45-degree field of view, fundus photo, 2048 by 1536 pixels:
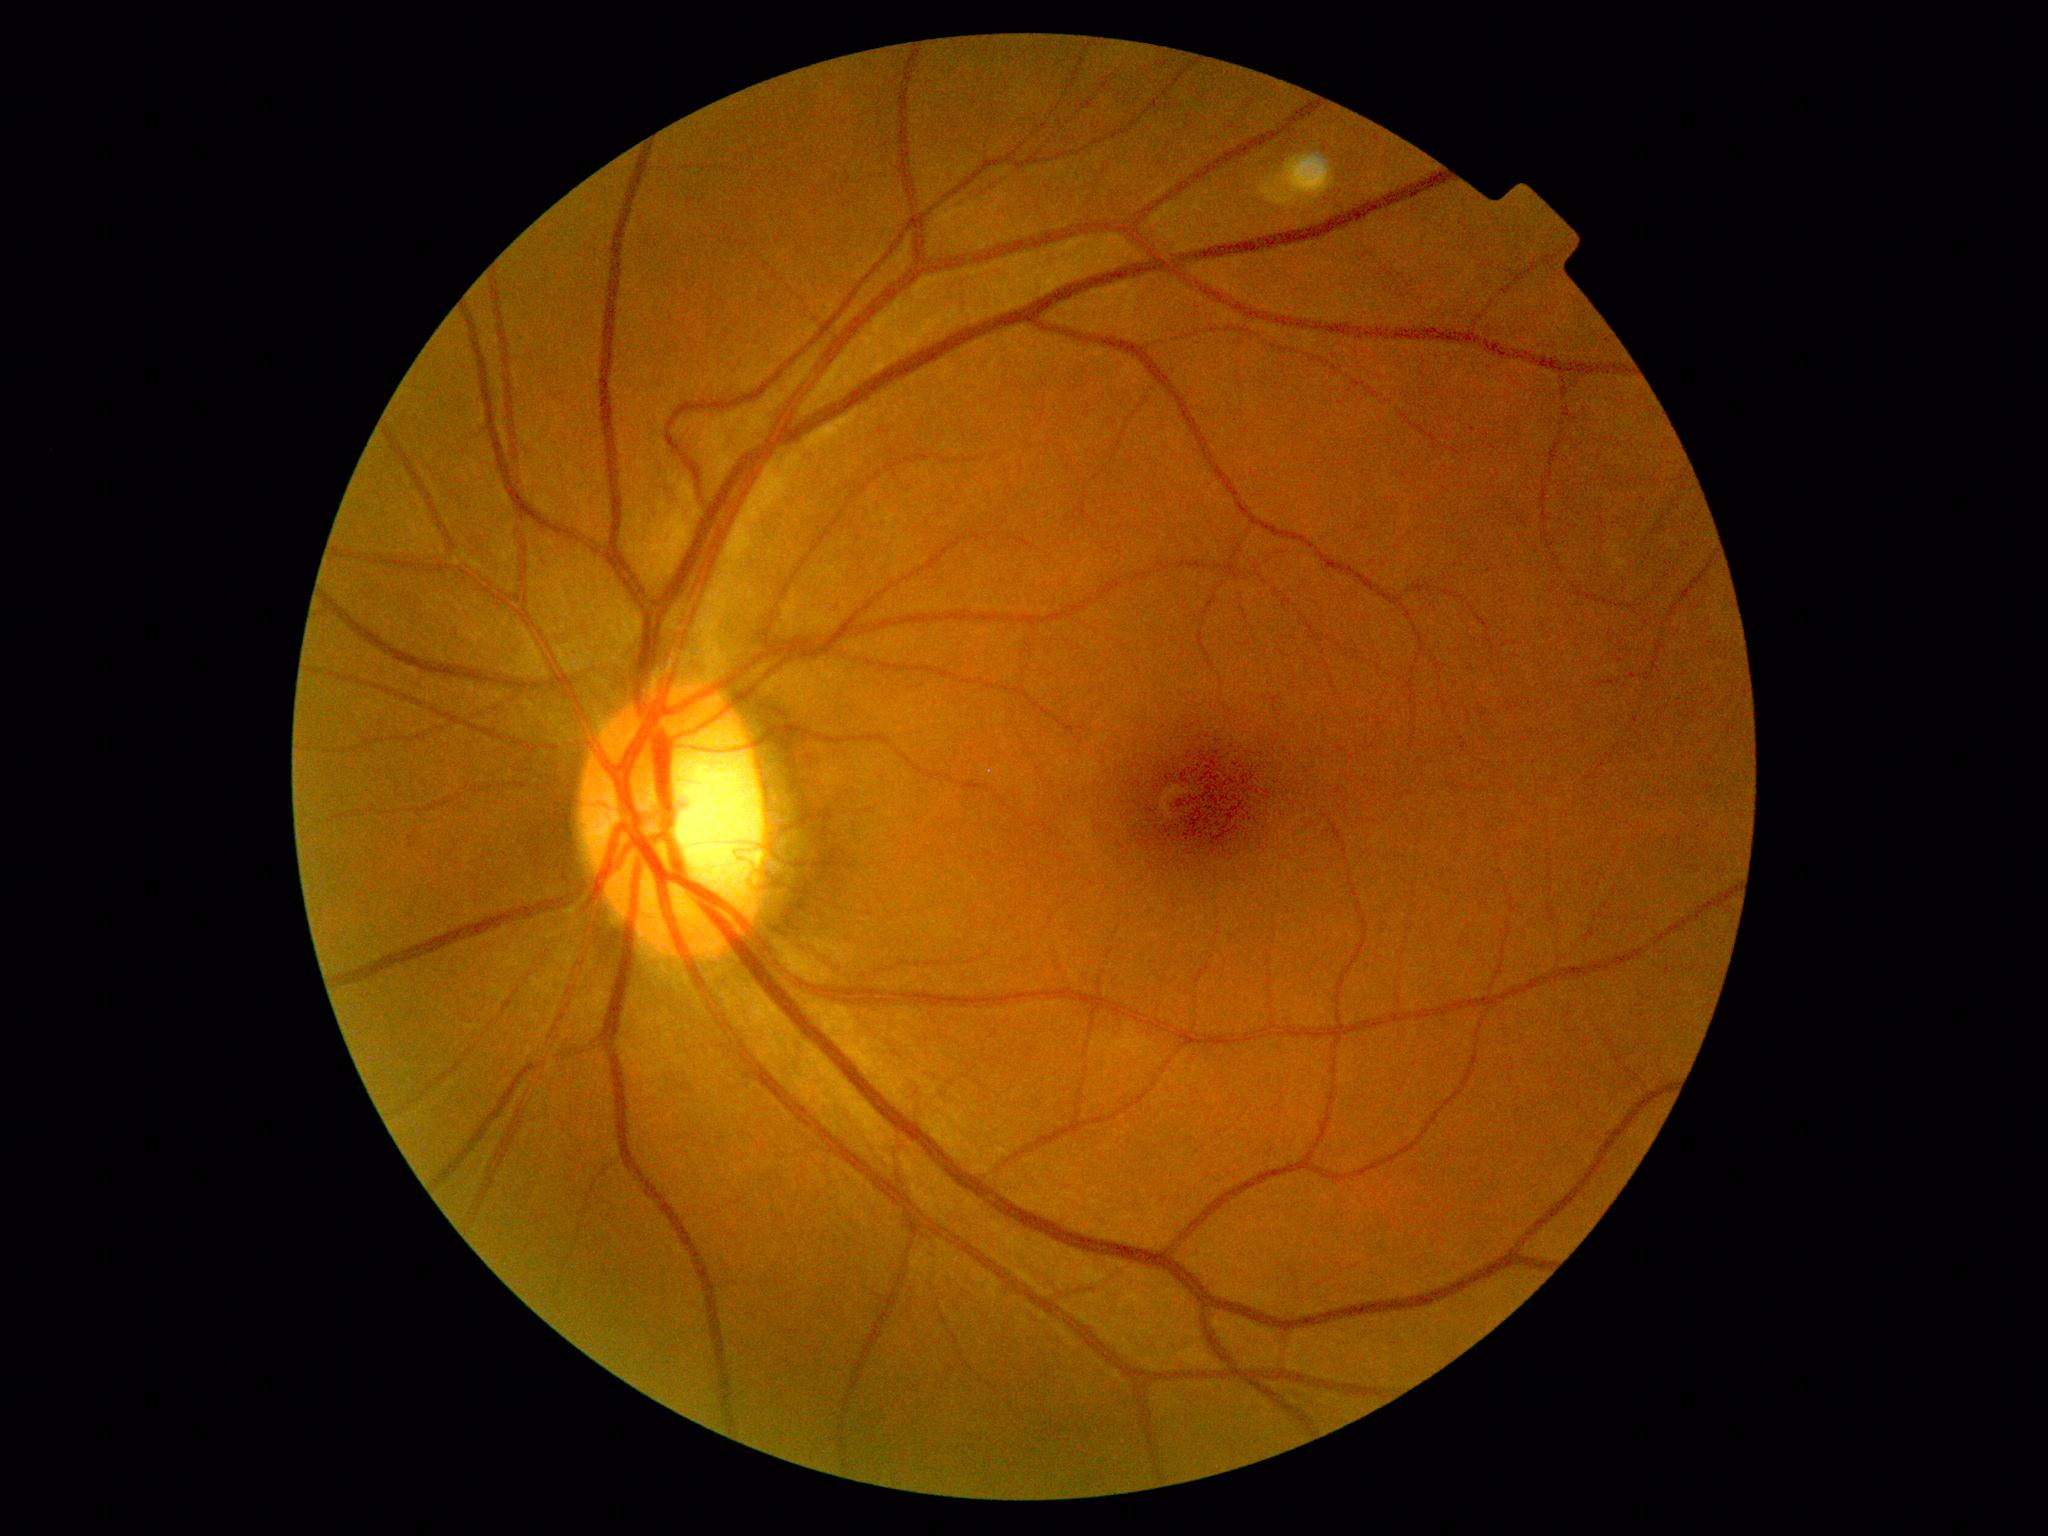 Retinopathy: no apparent retinopathy (grade 0).